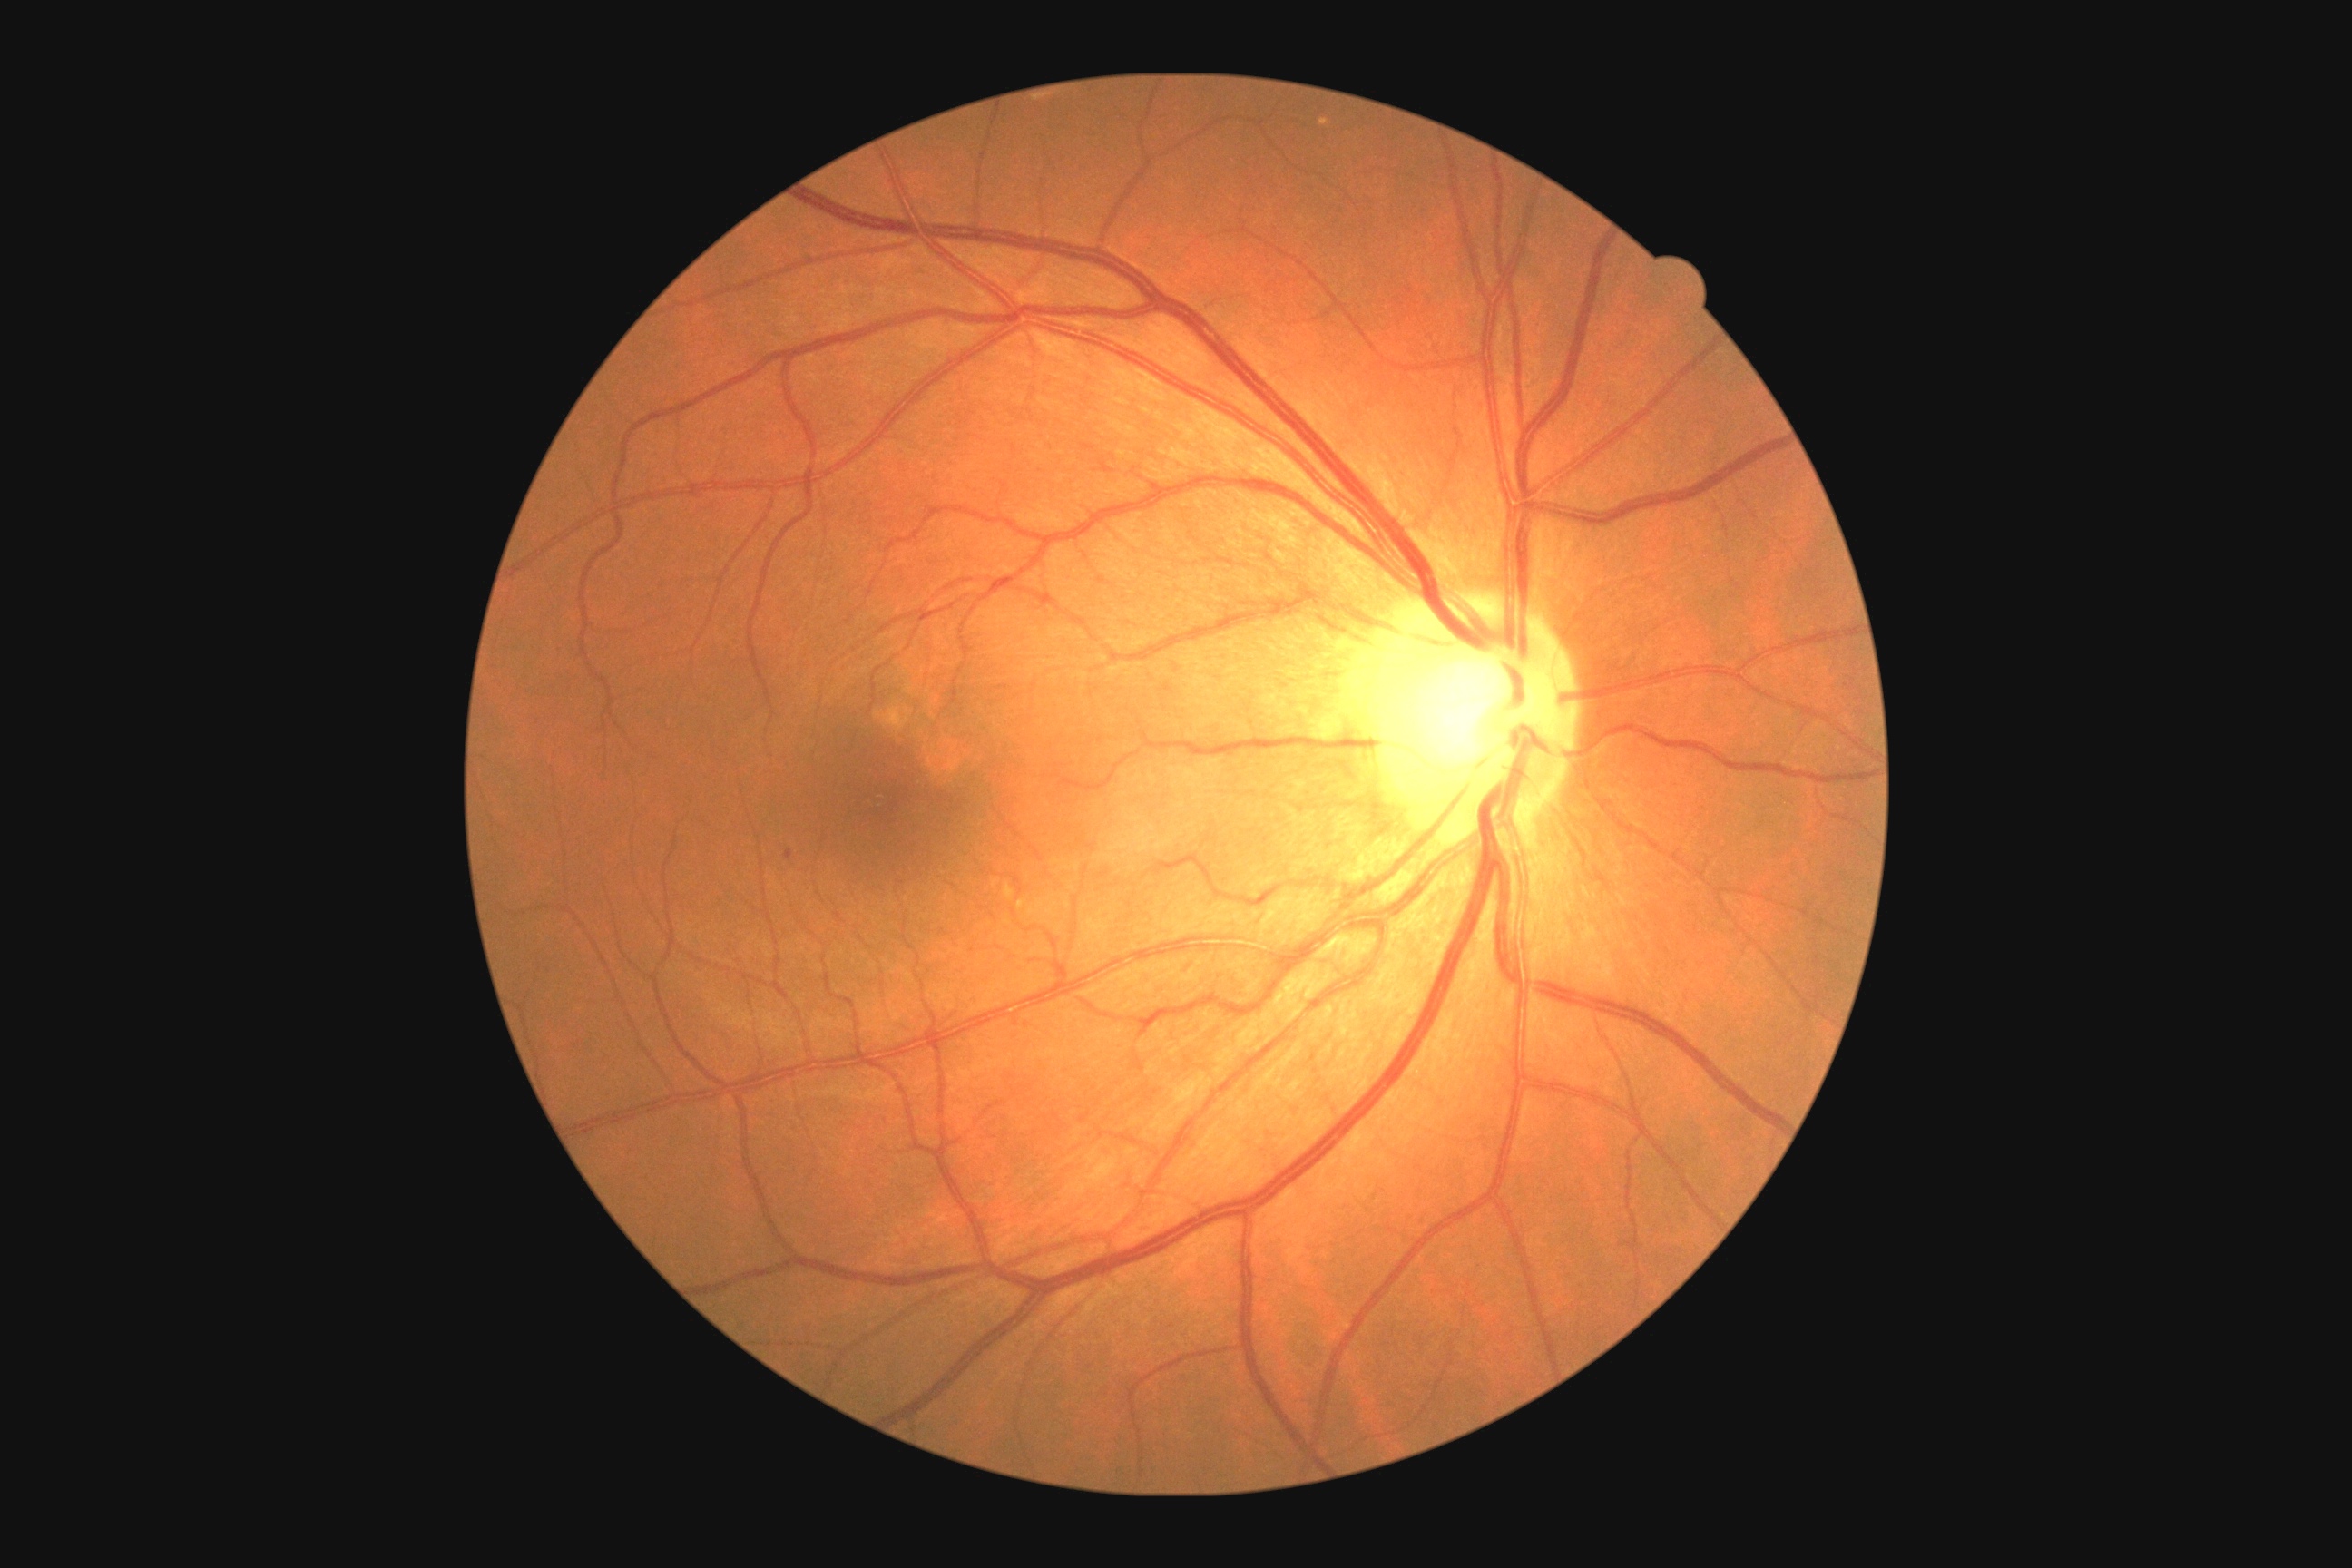
DR is 1
EXs: none detected
SEs: none detected
HEs: none detected
MAs: rect(785, 848, 792, 859)